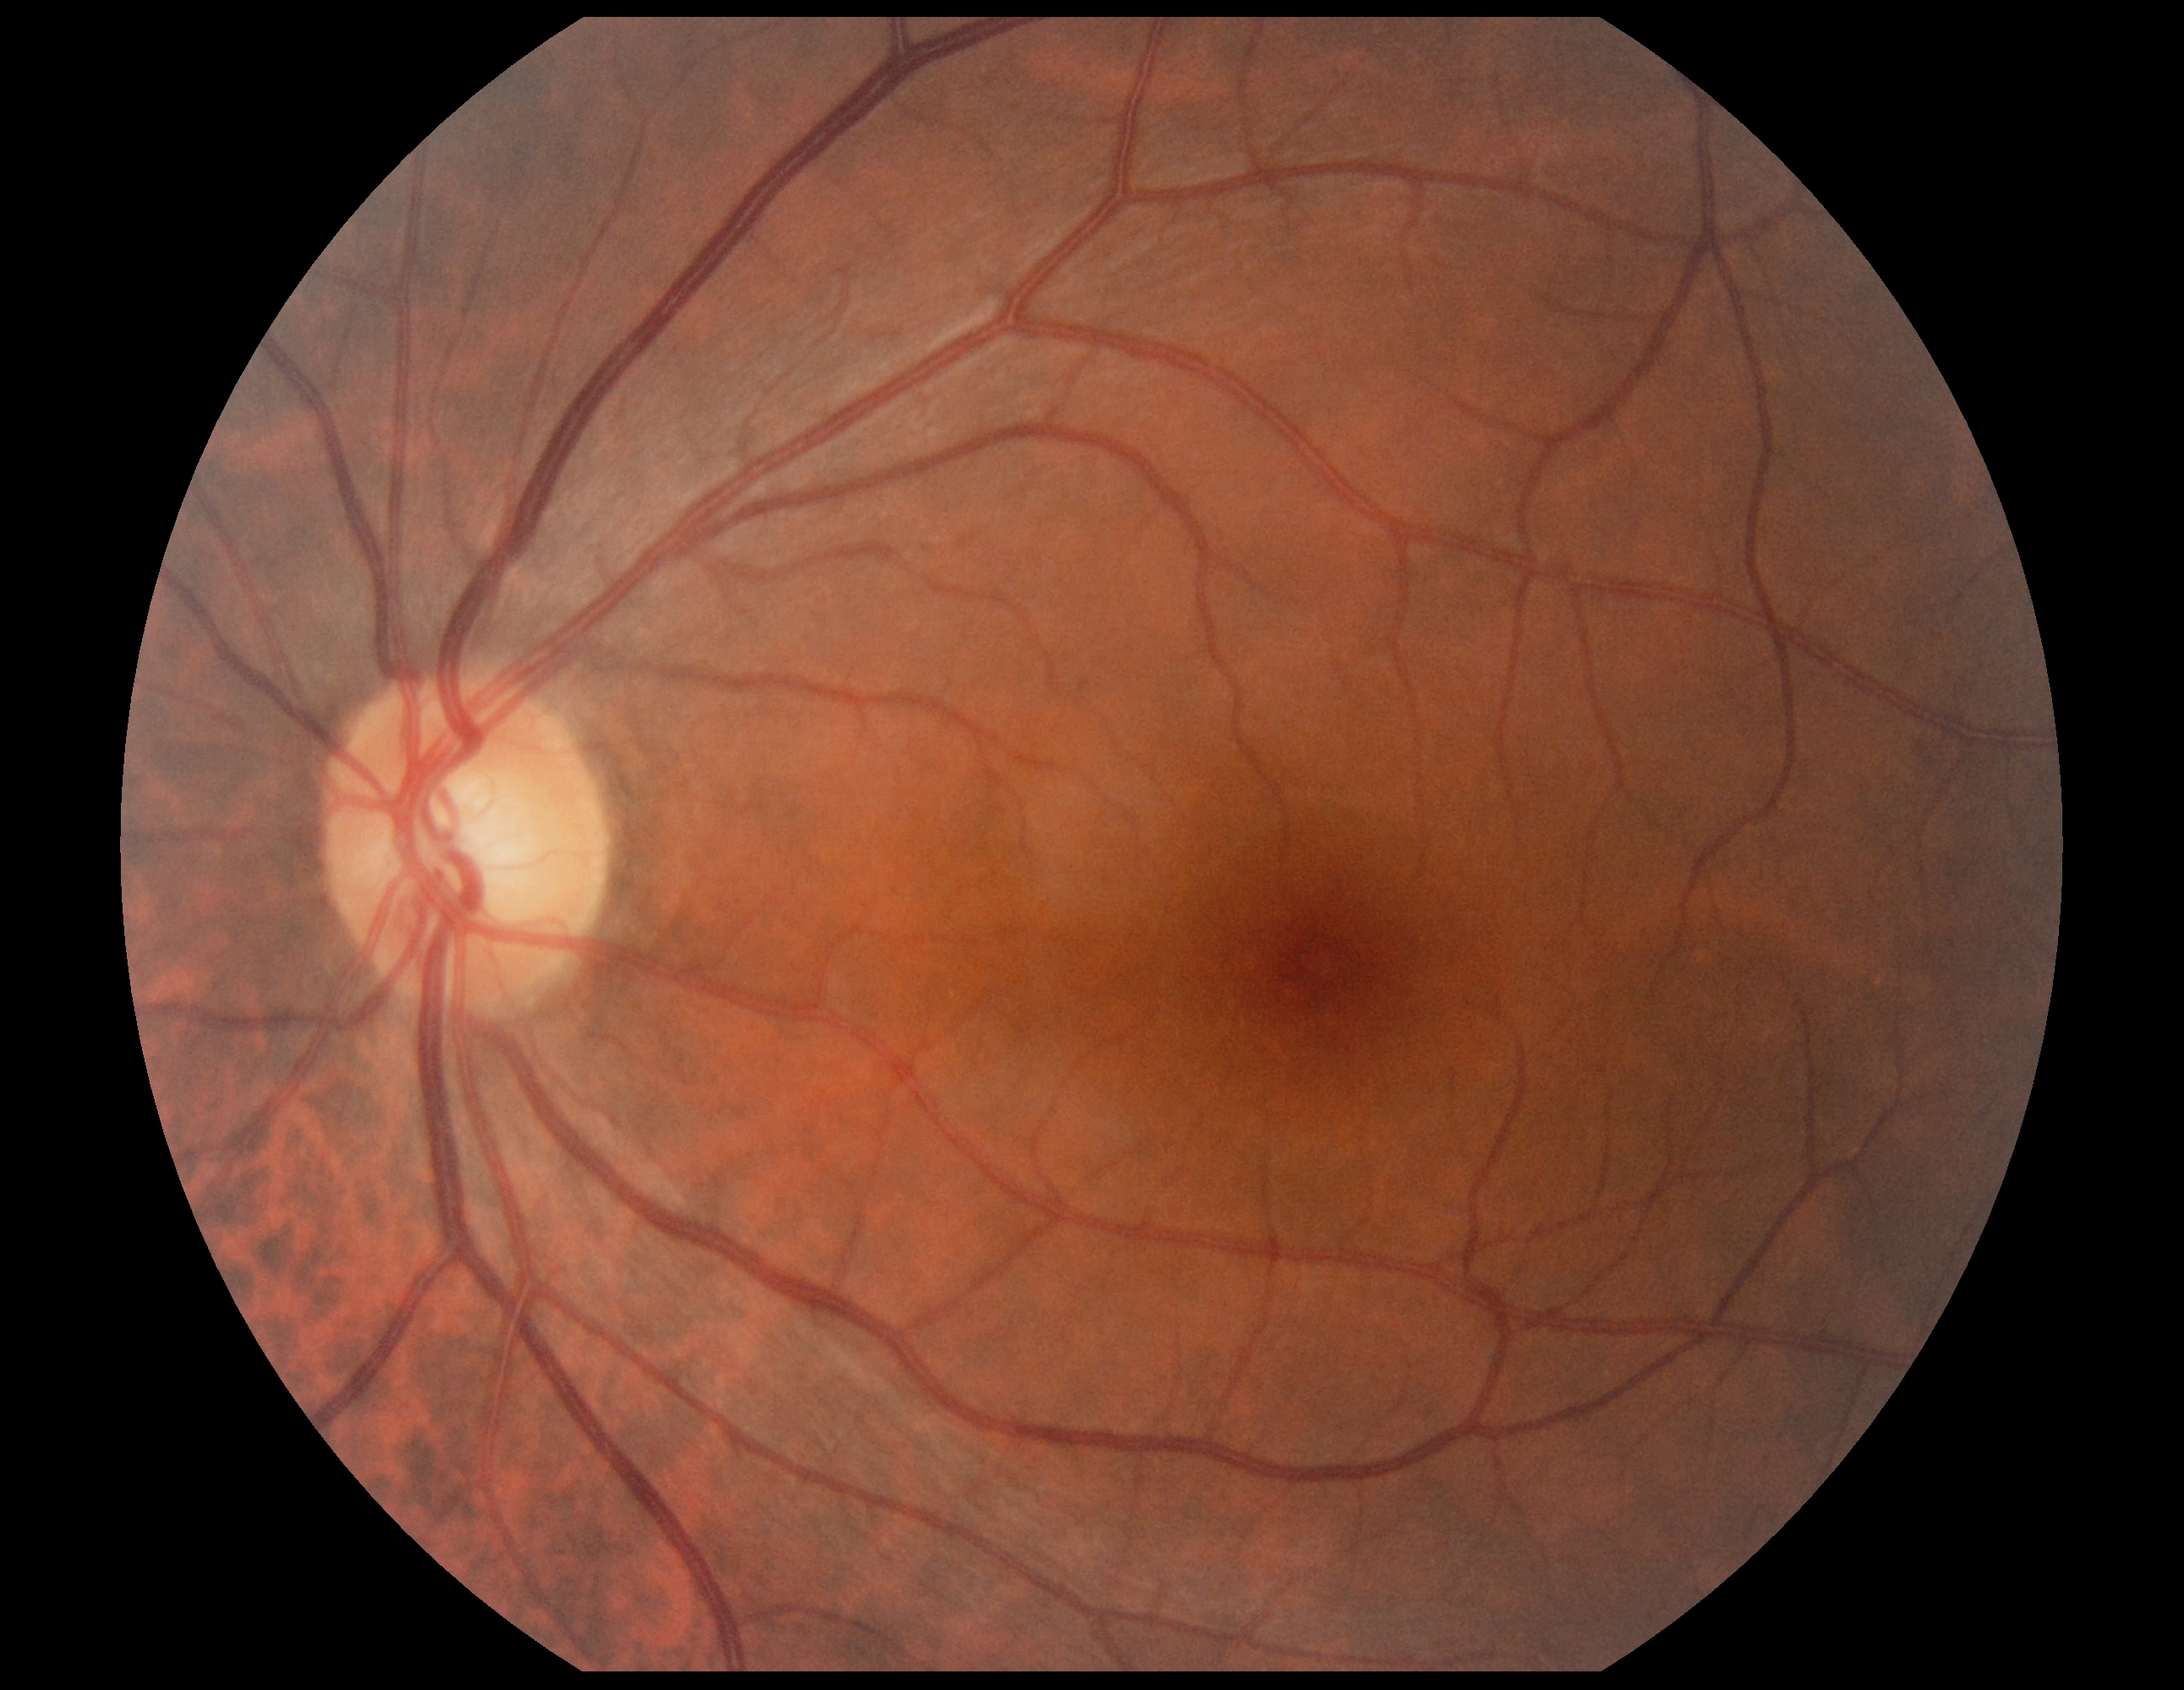 Annotations:
• diabetic retinopathy severity — grade 0 (no apparent retinopathy)